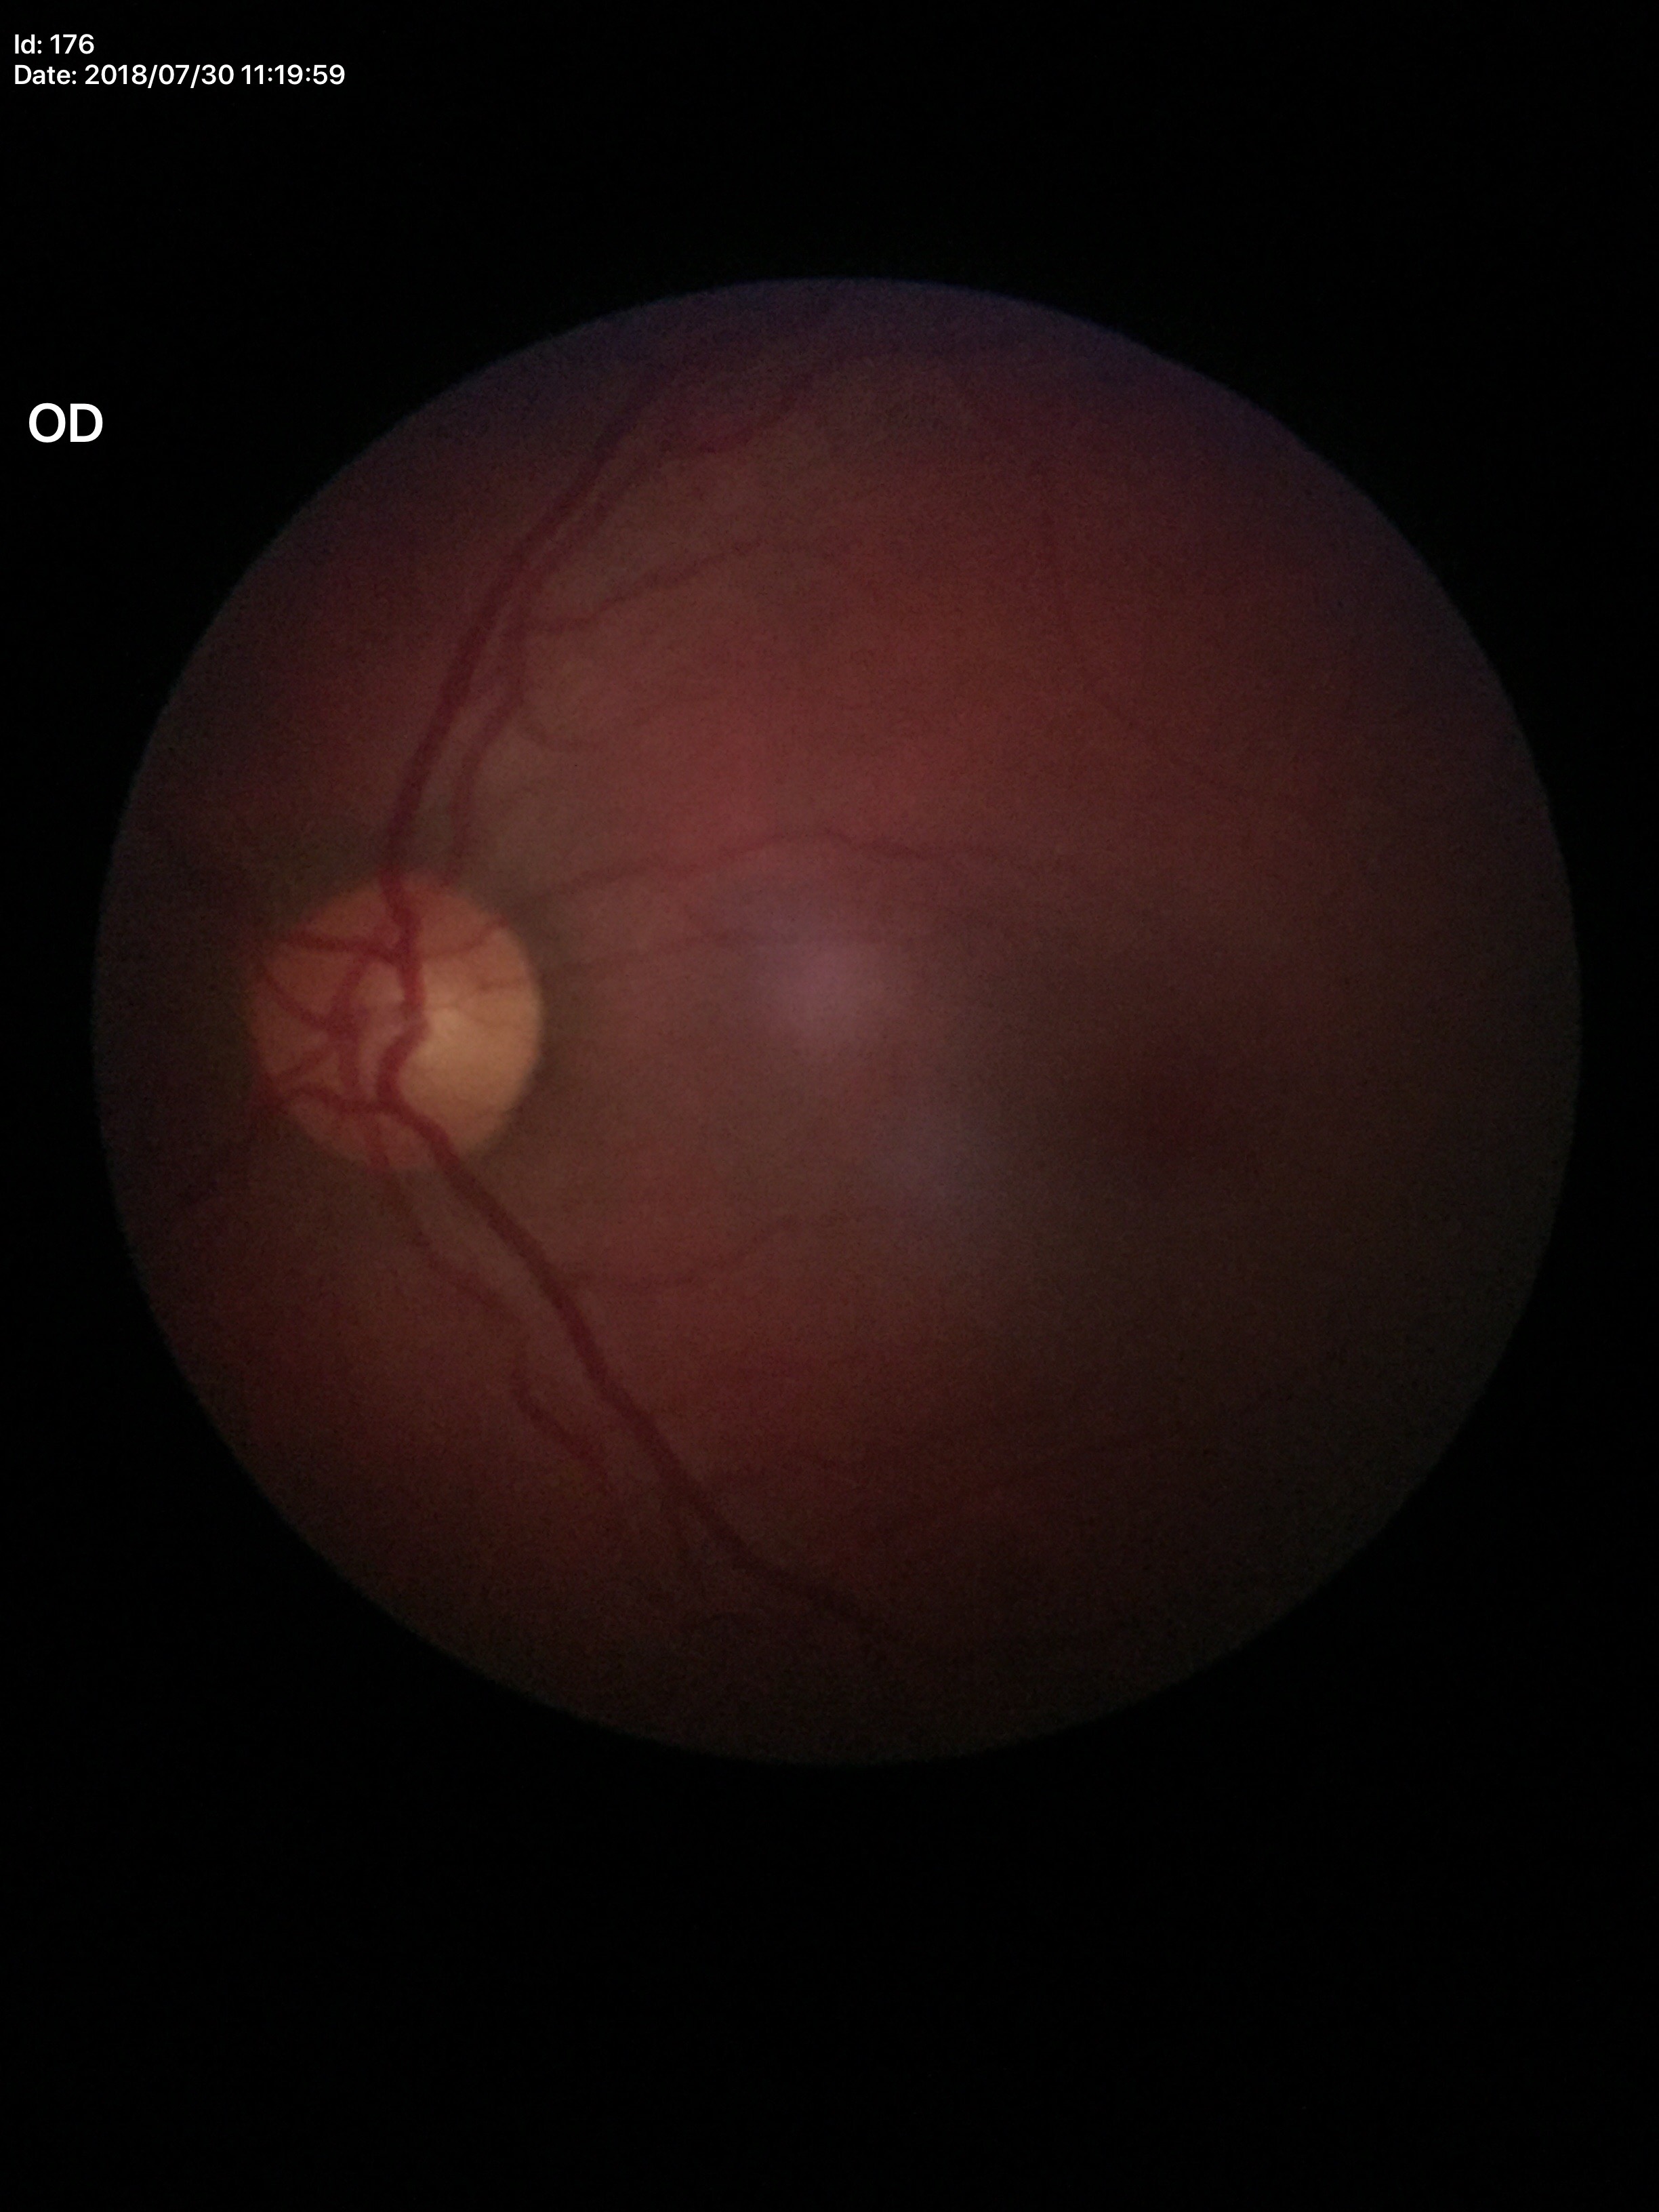 Glaucoma decision: no suspicious findings (1/5 graders called glaucoma suspect).
Vertical CDR is 0.54.